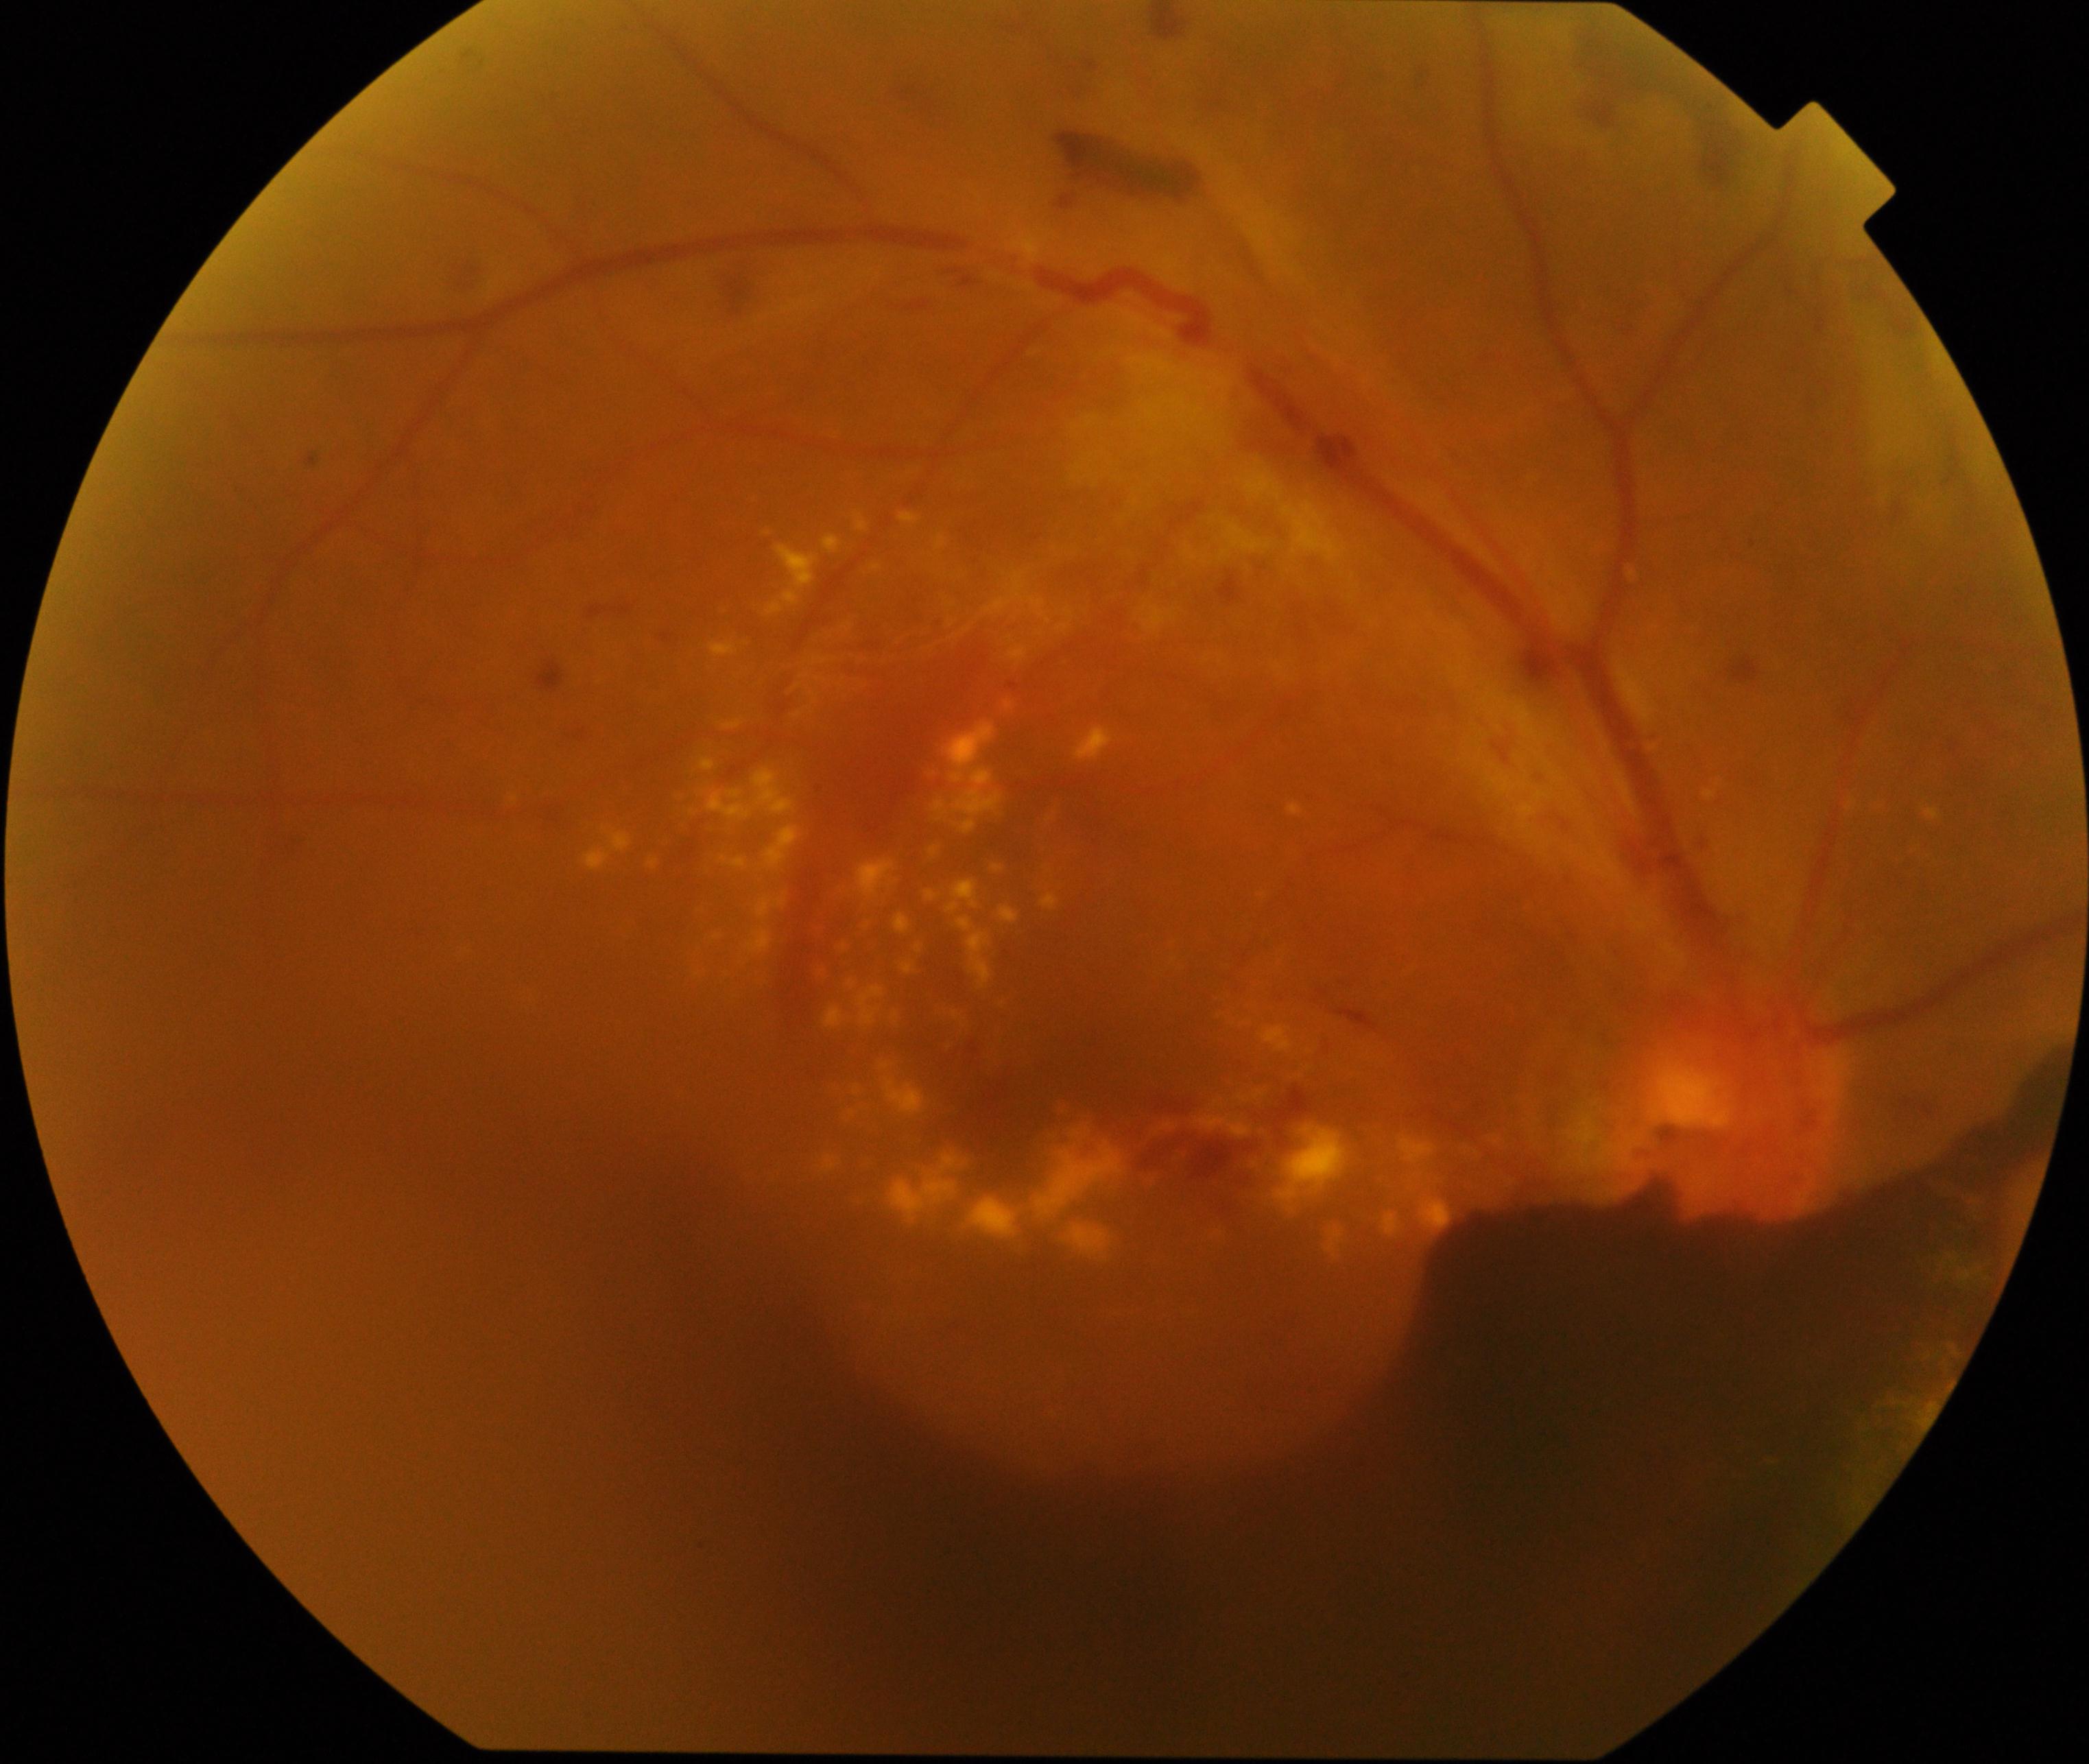
Primary finding: severe non-proliferative or proliferative diabetic retinopathy.